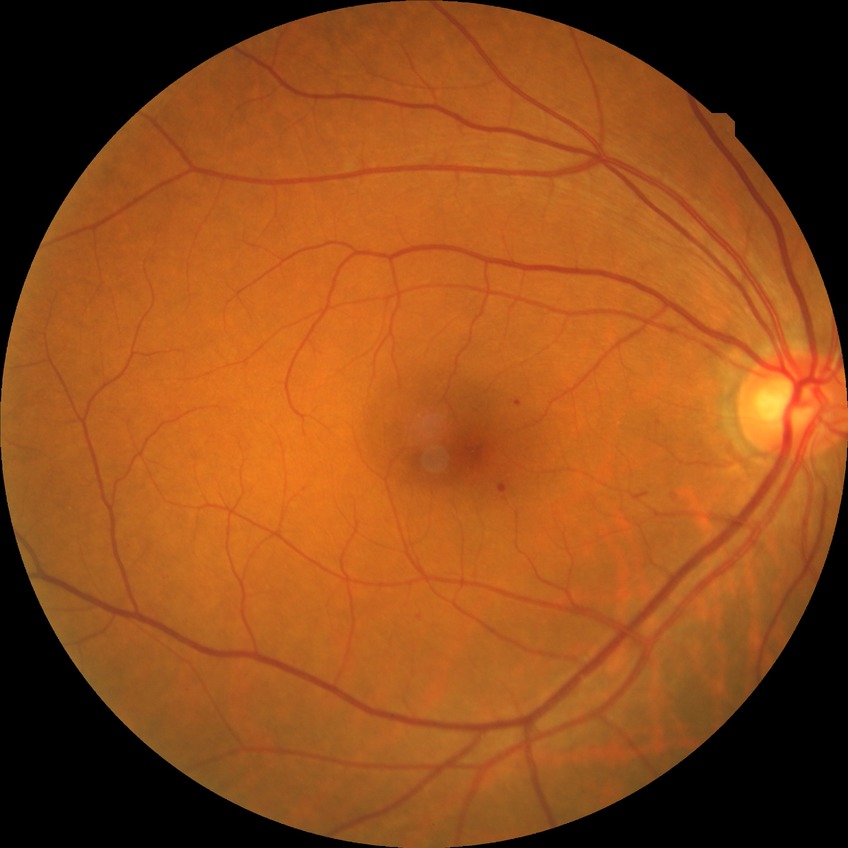
  davis_grade: simple diabetic retinopathy